No pharmacologic dilation:
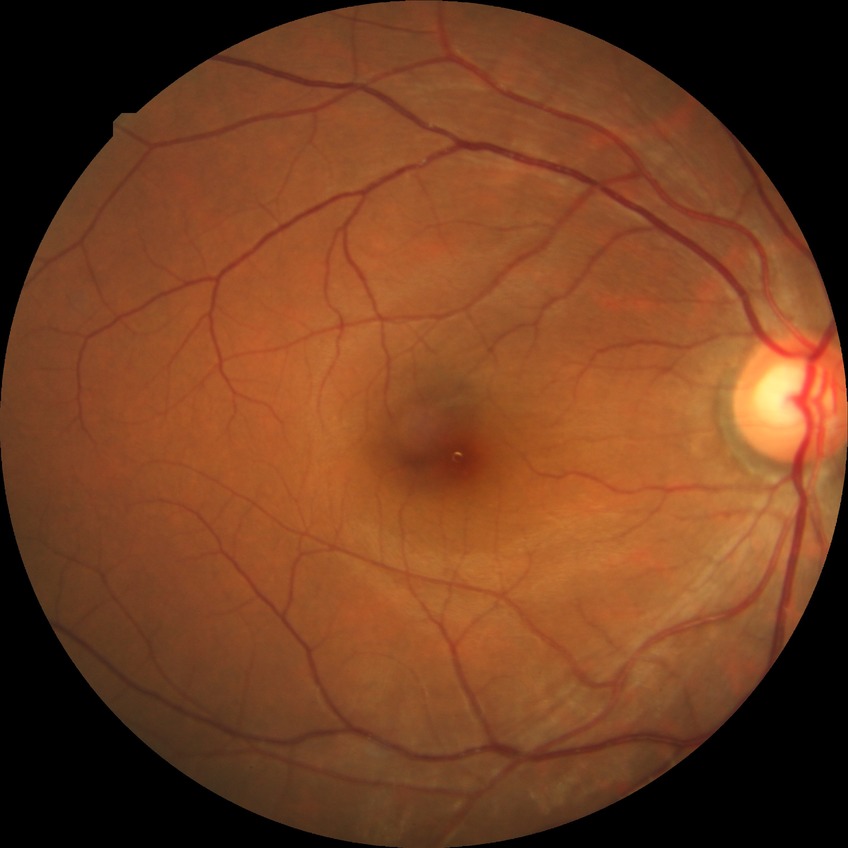

Diabetic retinopathy (DR): SDR (simple diabetic retinopathy).